Diabetic retinopathy graded by the modified Davis classification:
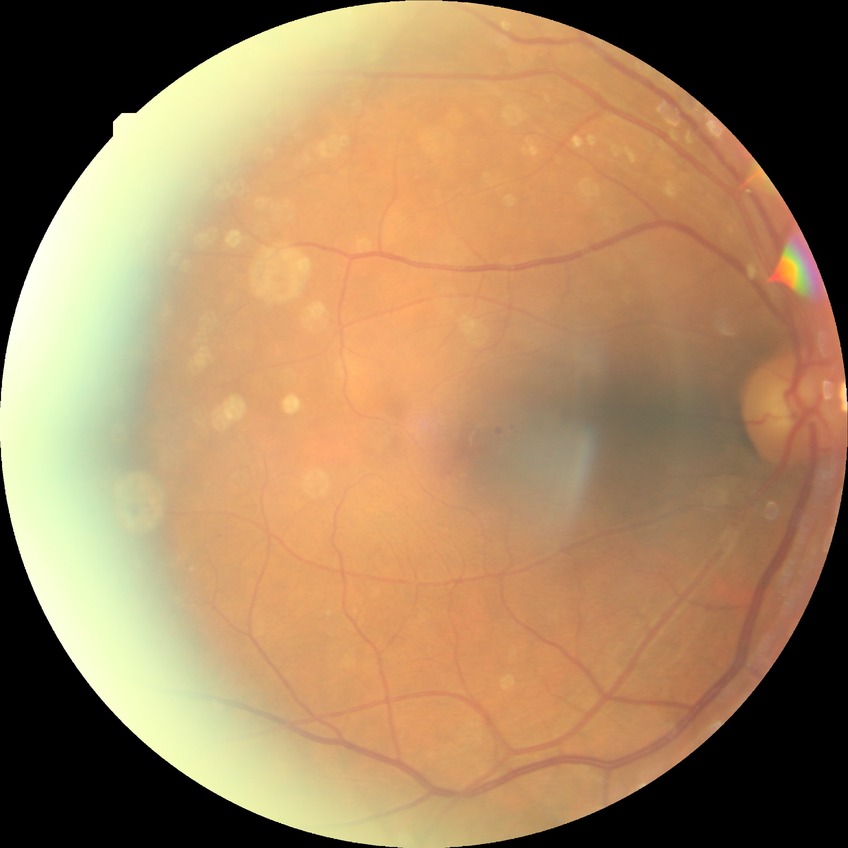 Davis stage: SDR.